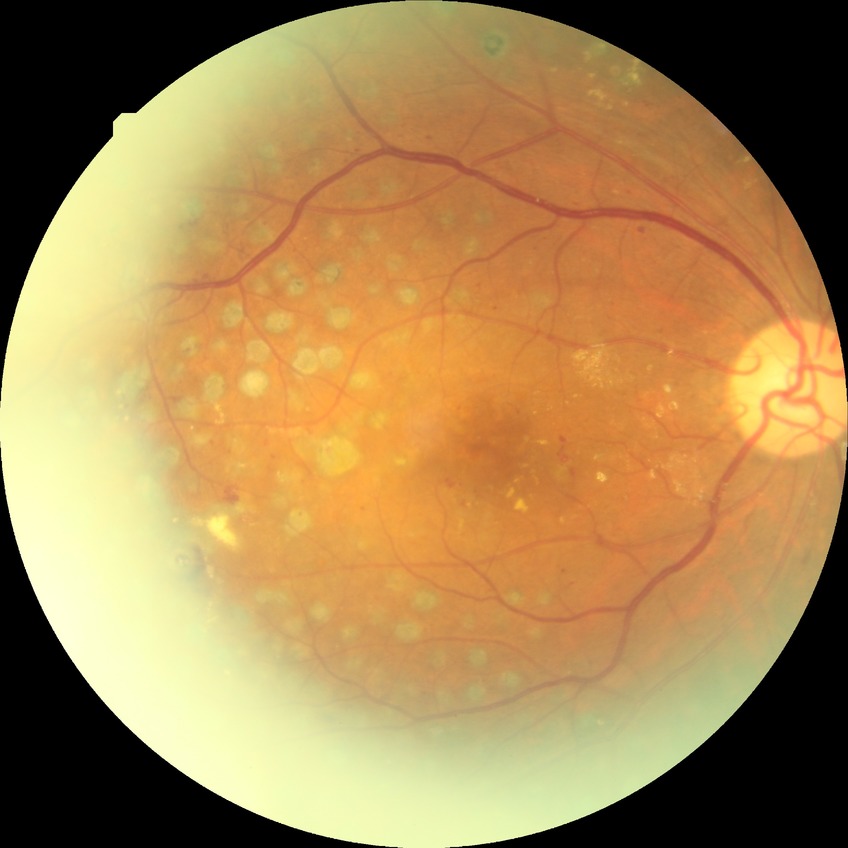
modified Davis grading: proliferative diabetic retinopathy.